2228 x 1652 pixels
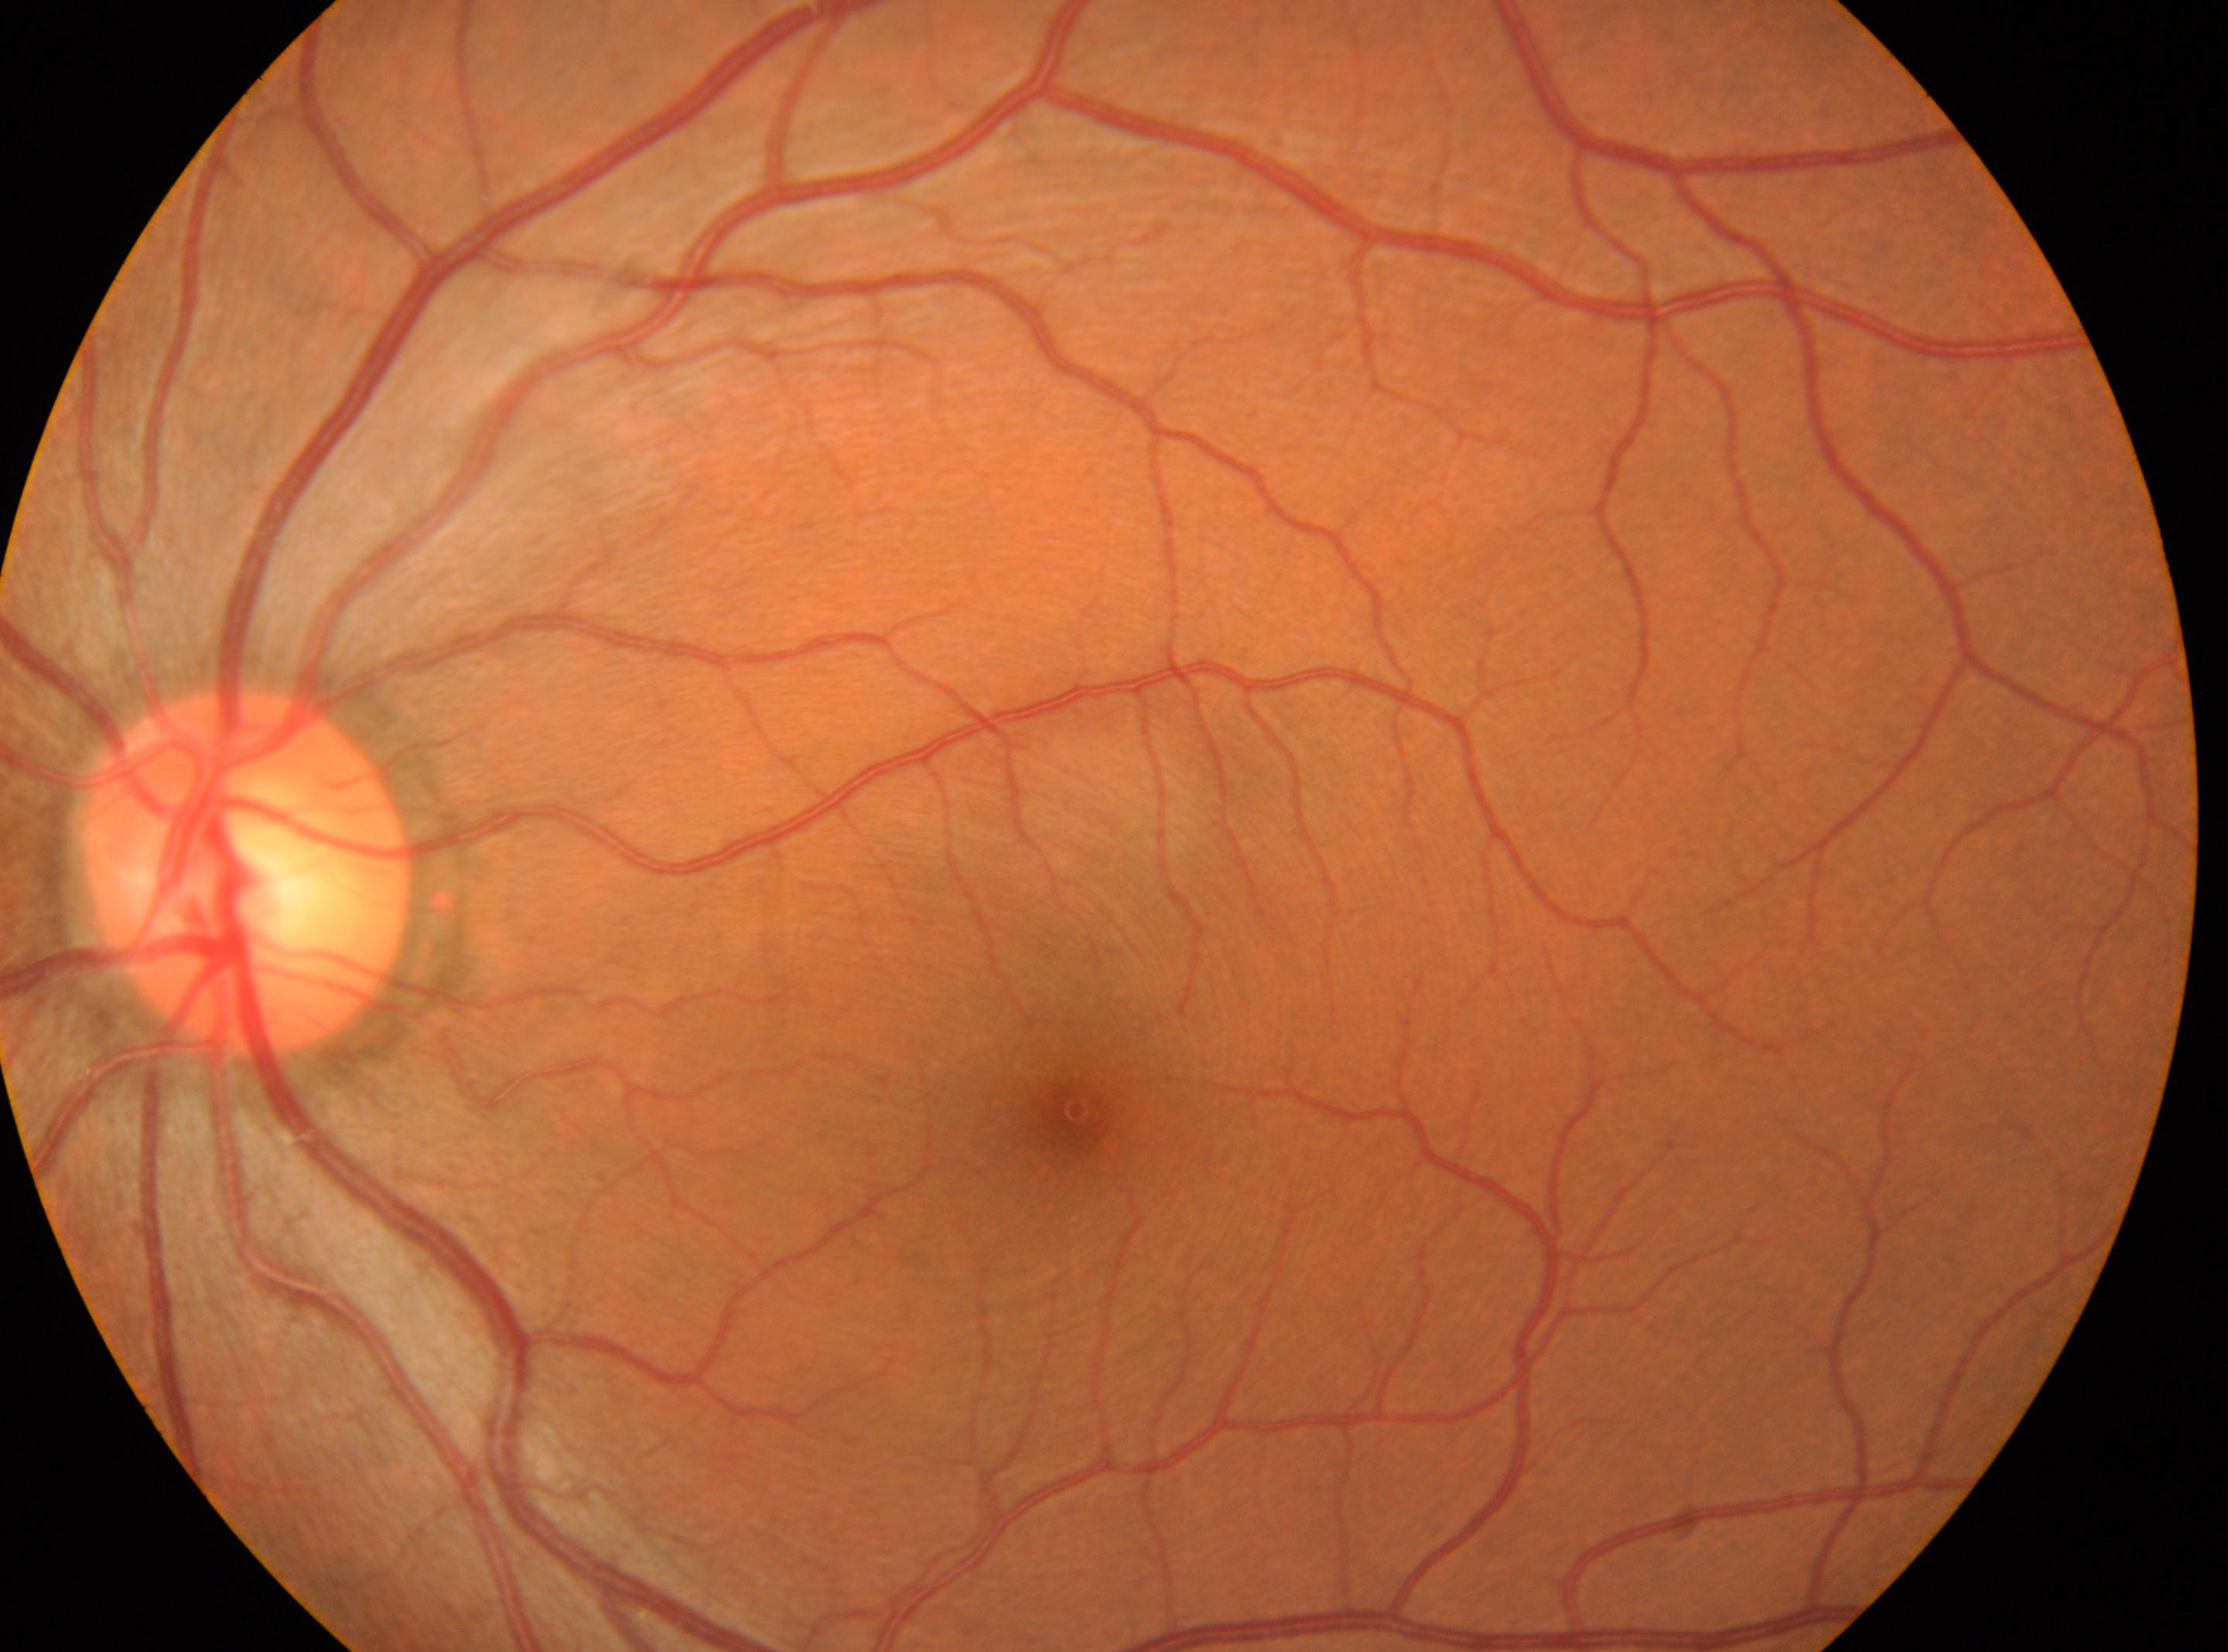

This is the left eye. The foveal center is at [1072, 1111]. ONH located at [246, 871]. DR grade is 0 (no apparent retinopathy).